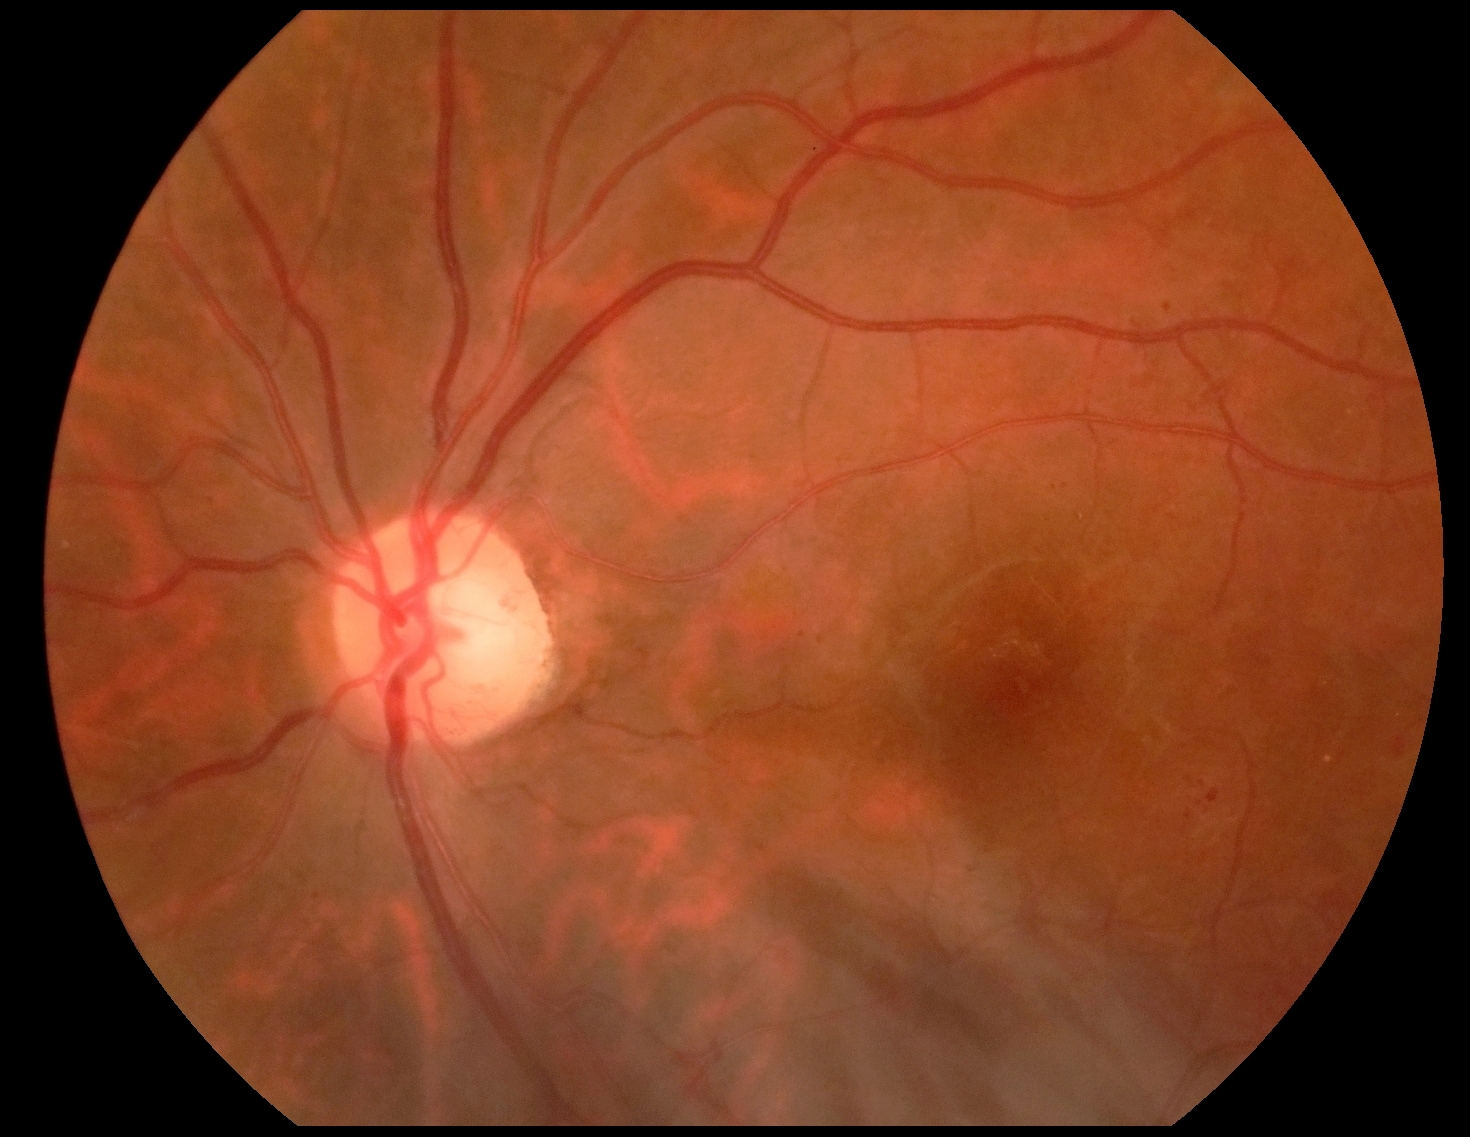 DR: 2.